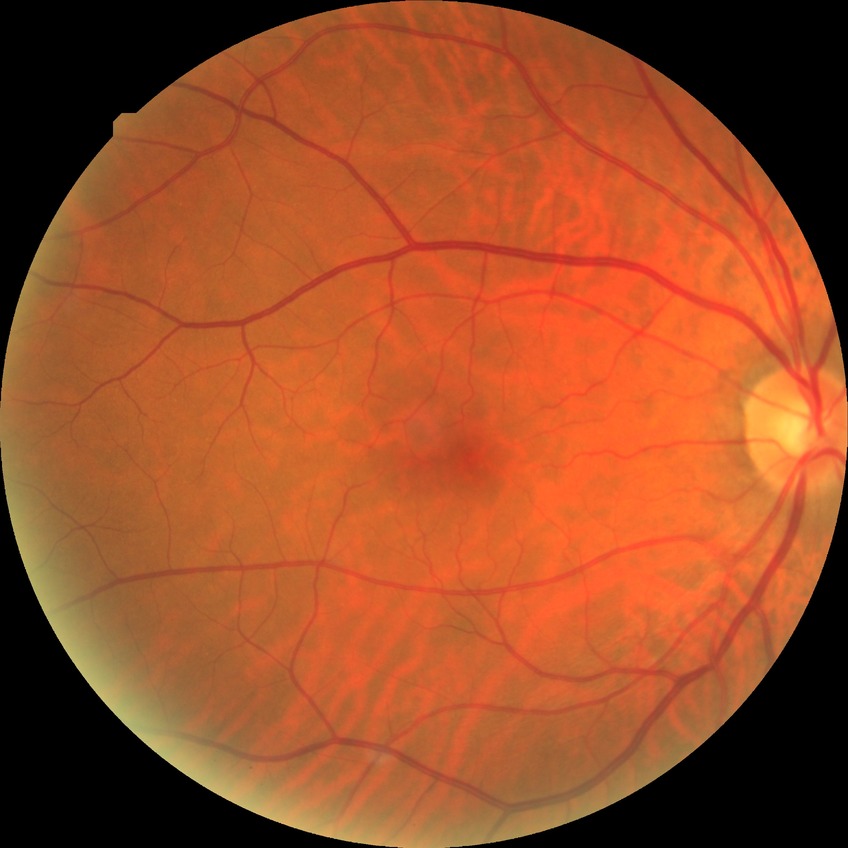

Diabetic retinopathy (DR) is NDR (no diabetic retinopathy).